848x848. 45-degree field of view. Nonmydriatic fundus photograph. NIDEK AFC-230 fundus camera. Color fundus image: 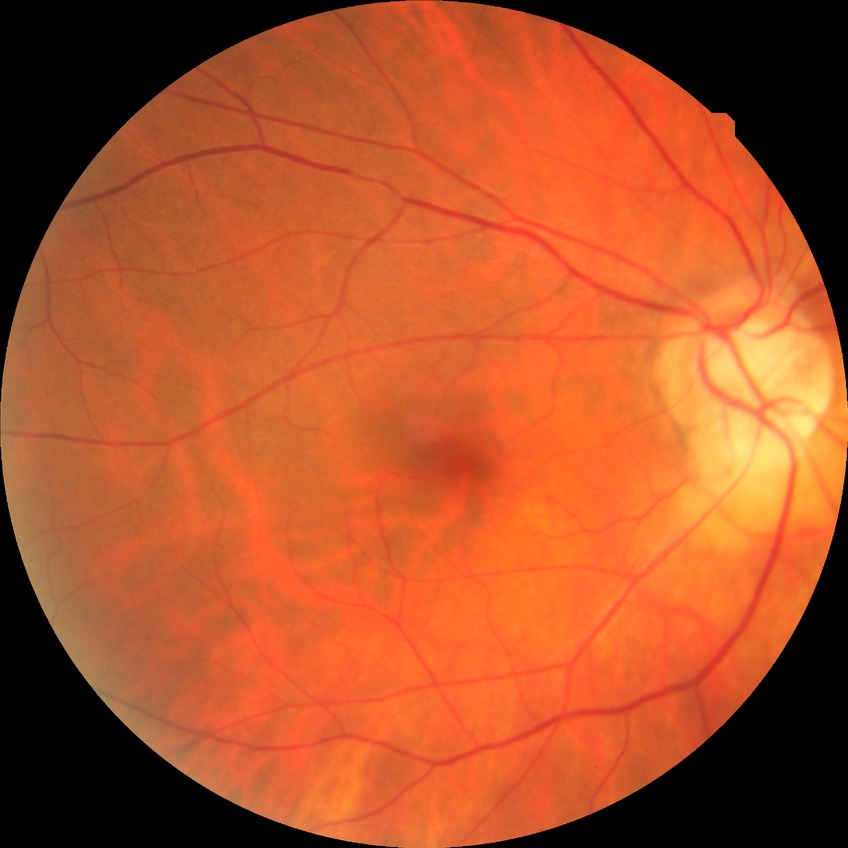
DR grade: NDR.